1240 x 1240 pixels · captured with the Phoenix ICON (100° field of view) · pediatric wide-field fundus photograph
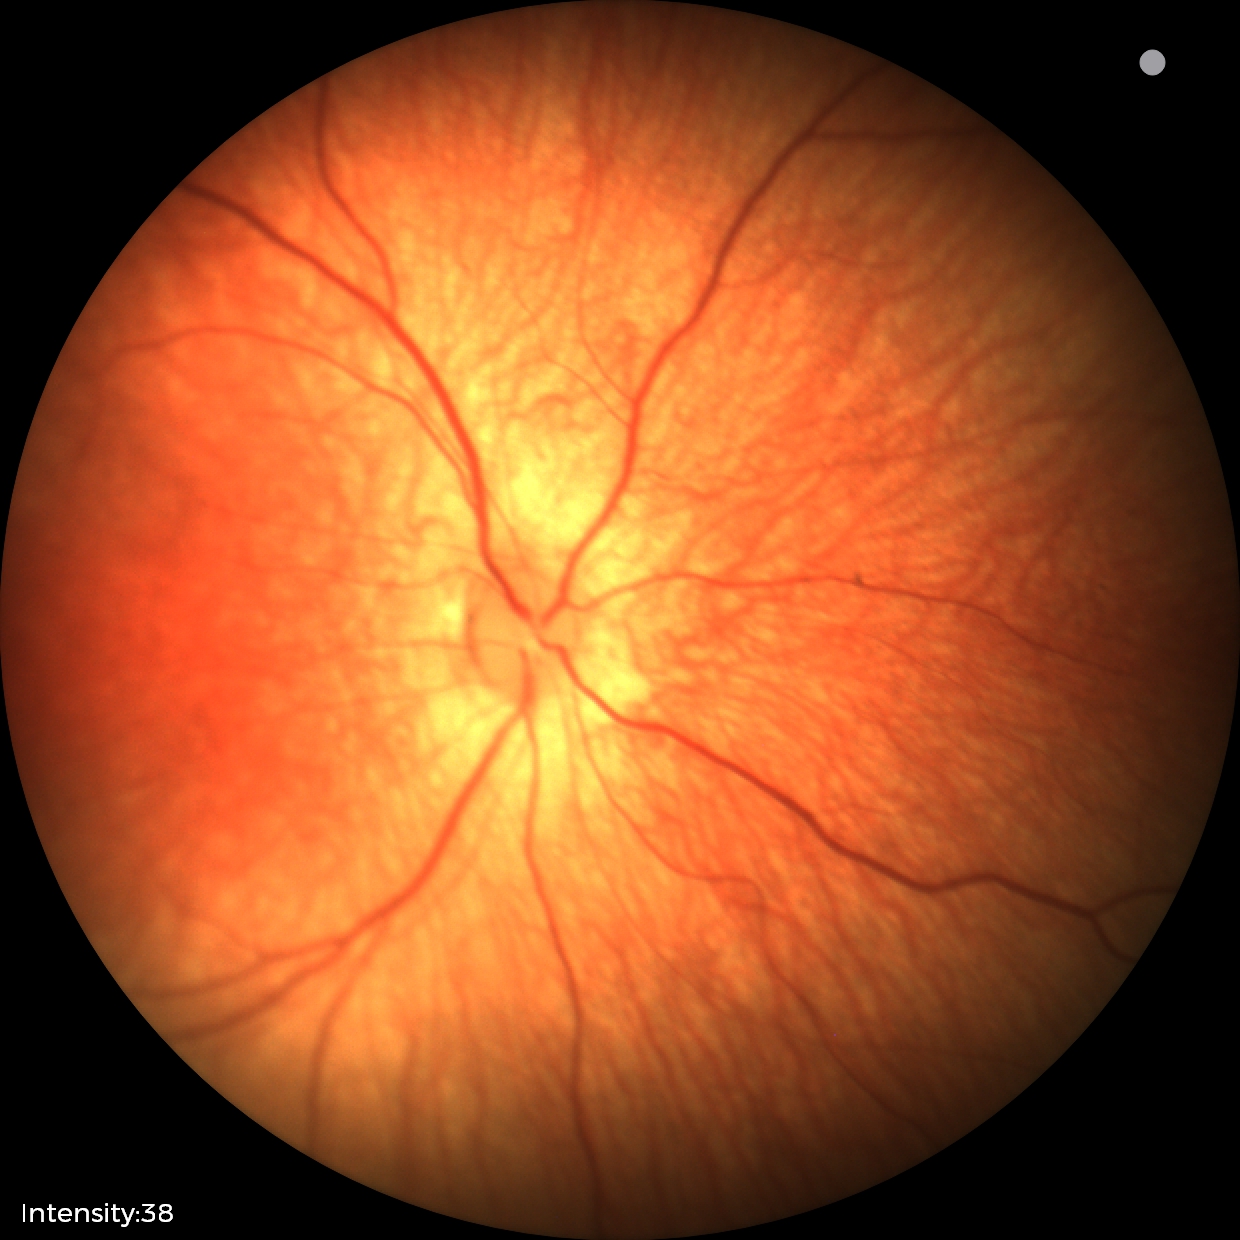
Normal screening examination.